Pediatric wide-field fundus photograph
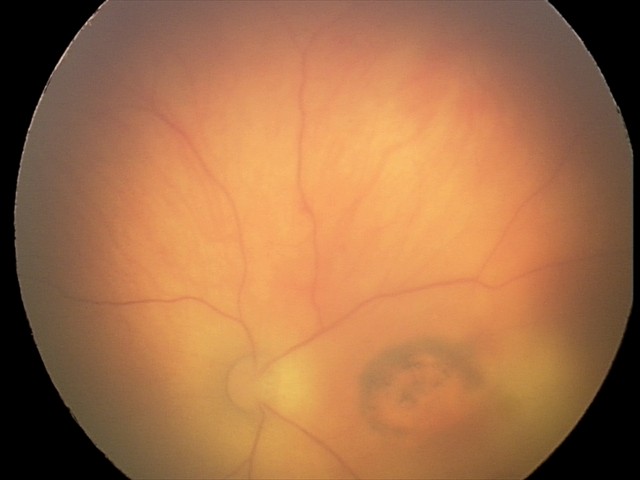 Assessment: toxoplasmosis chorioretinitis.